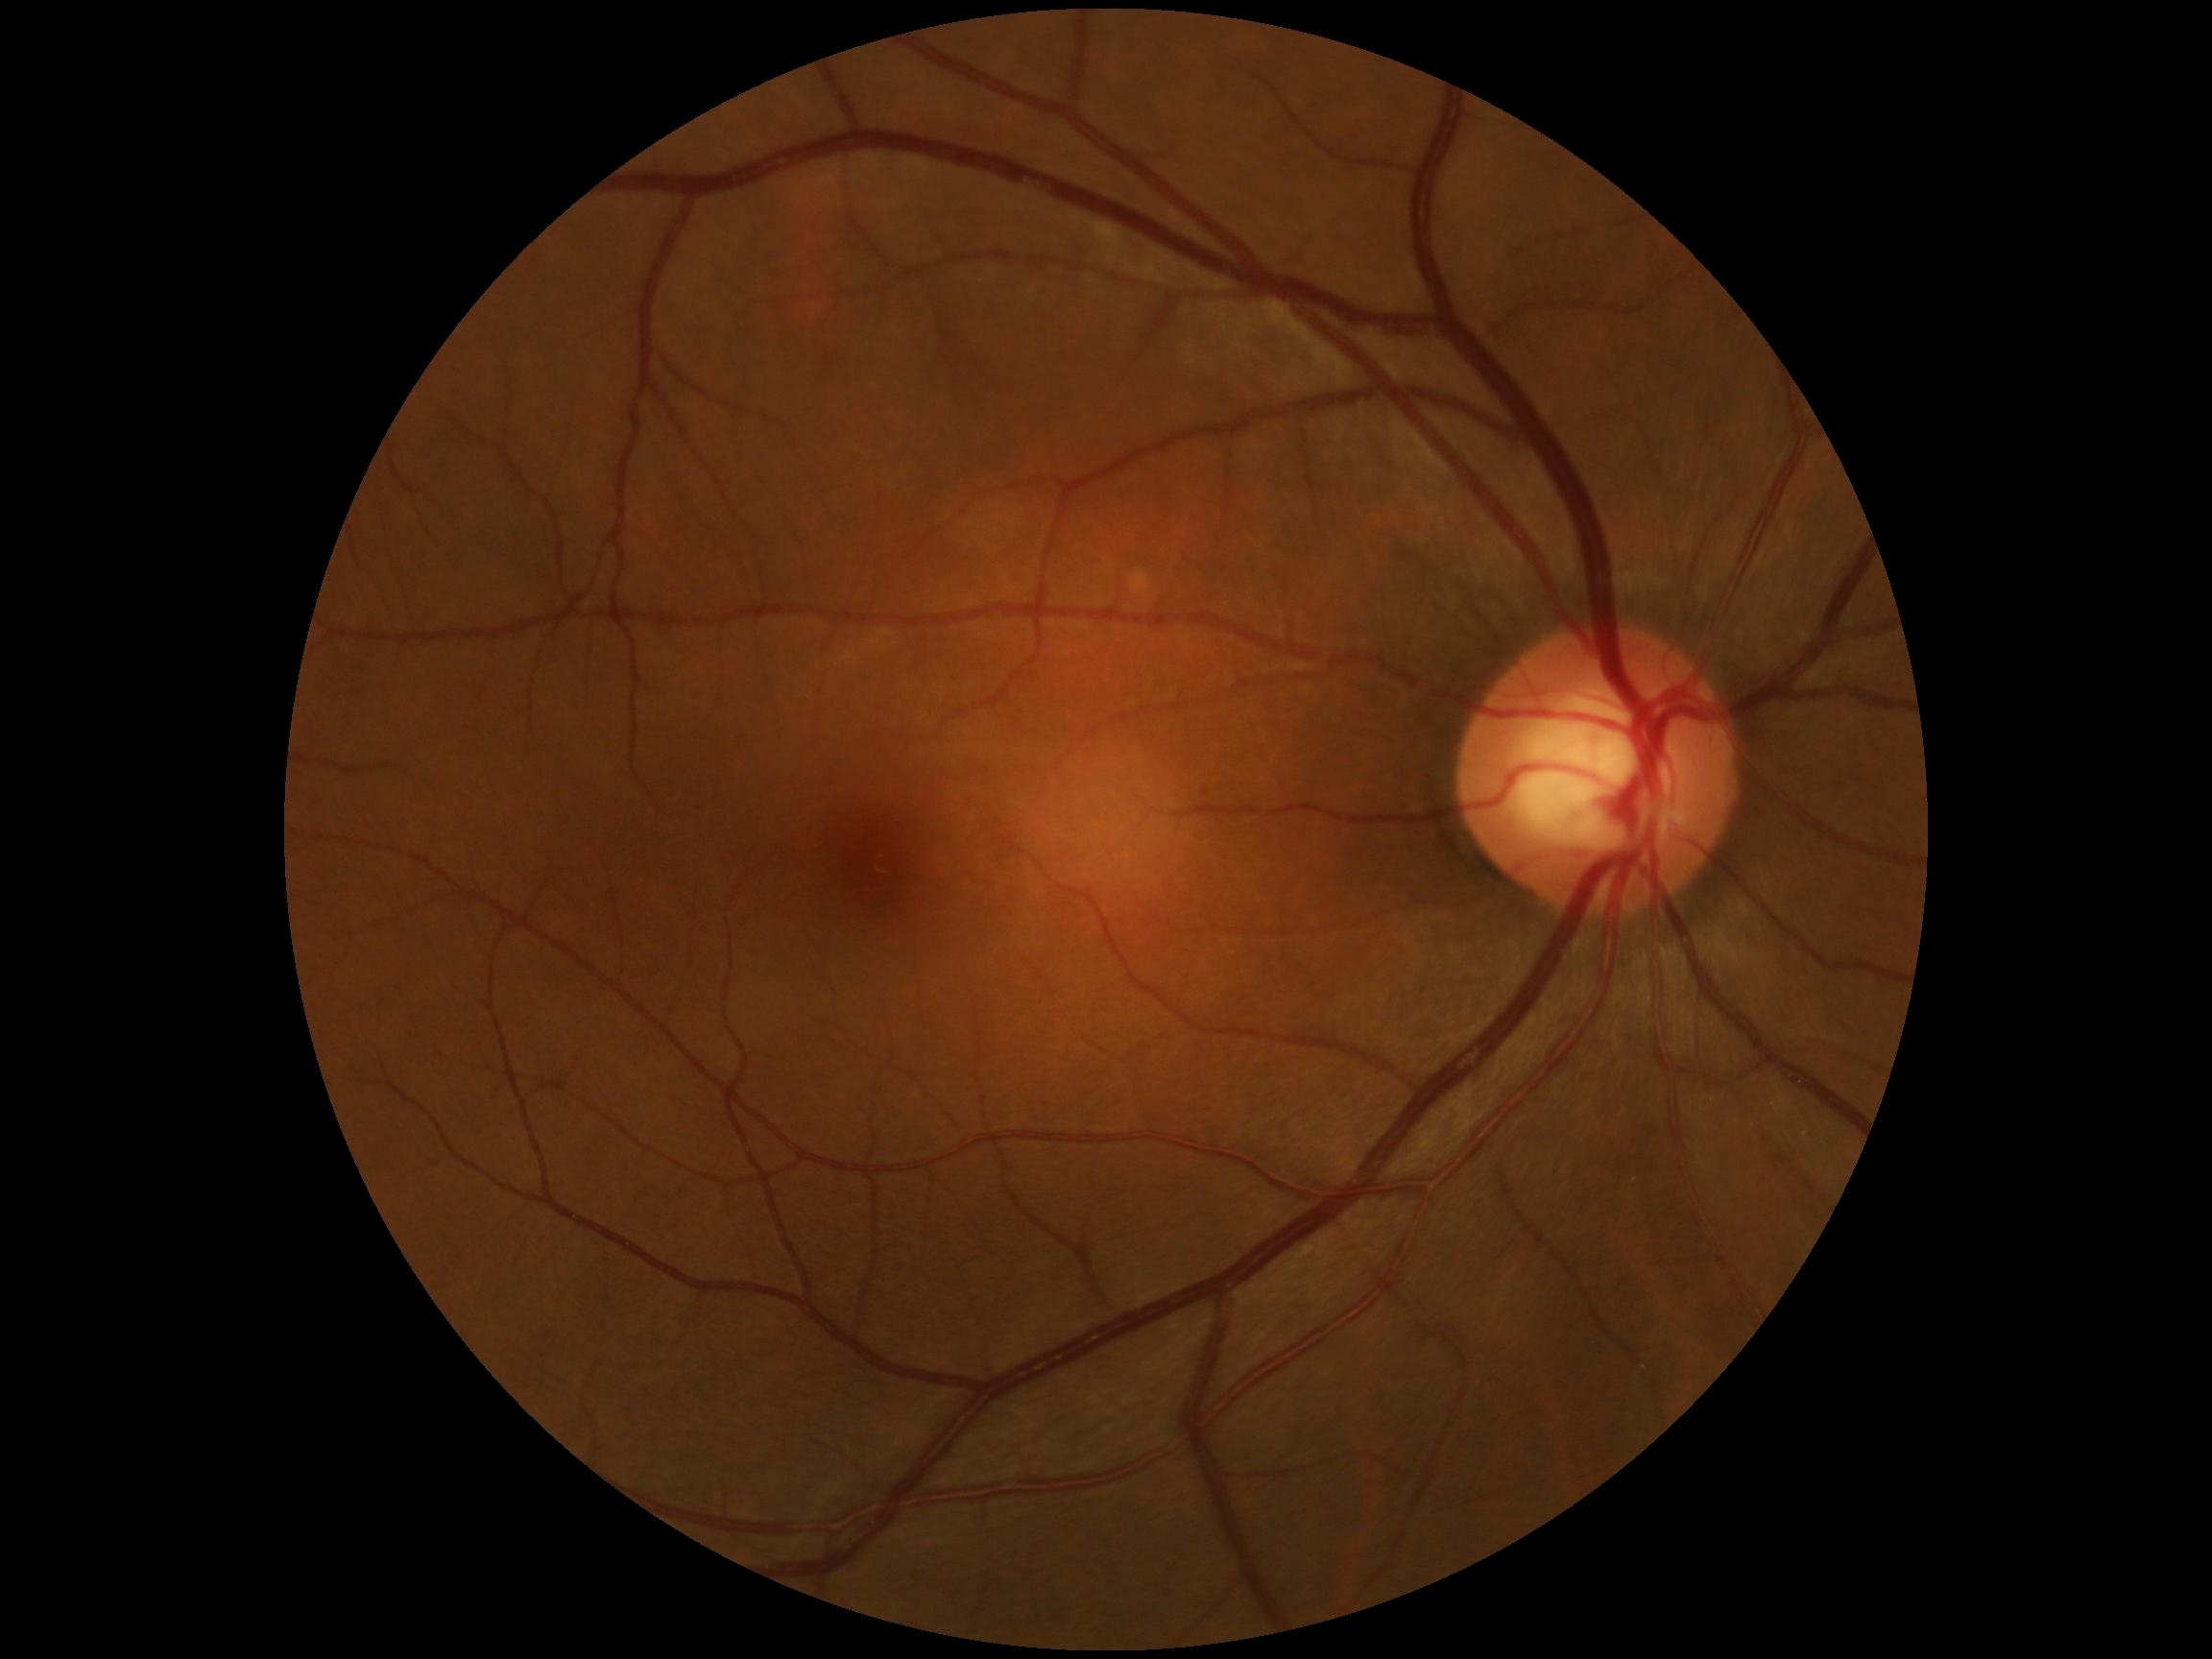 DR stage is no apparent diabetic retinopathy (grade 0). No apparent diabetic retinopathy.